Dilated-pupil acquisition, 50-degree field of view, image size 2228x1652, Topcon TRC-50DX, color fundus image — 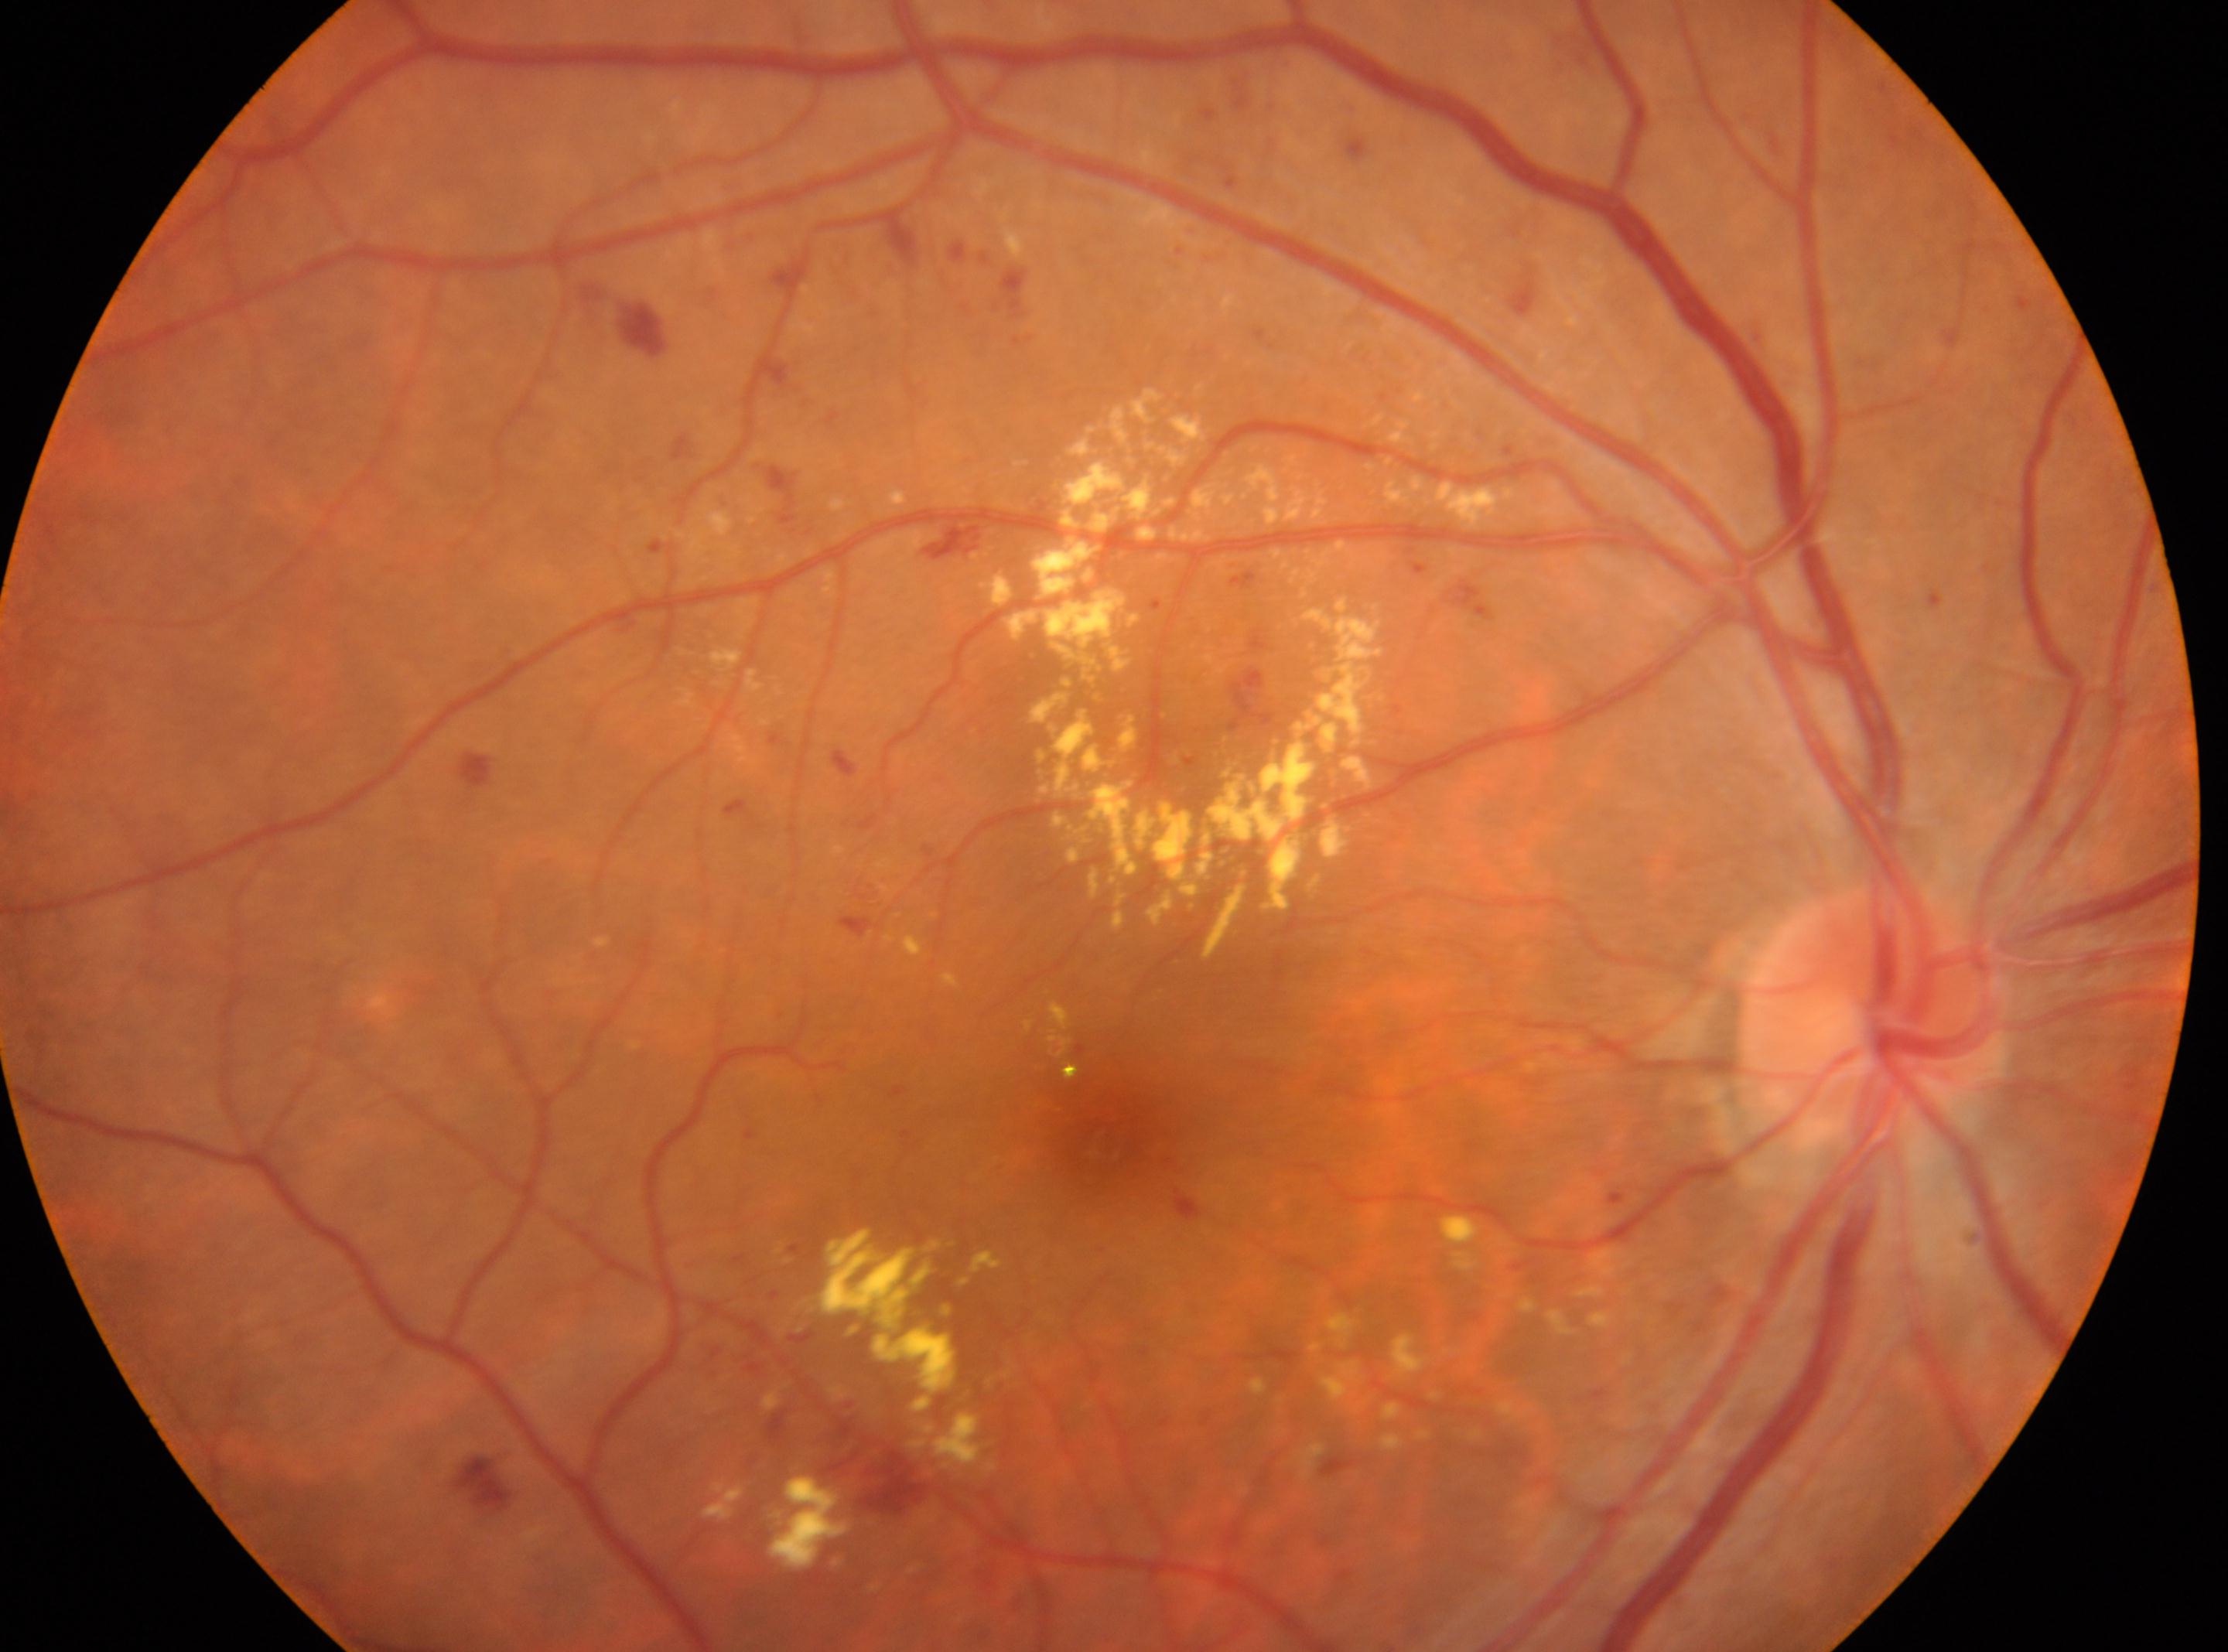 Findings:
* optic nerve head: x=1869, y=1015
* laterality: right eye
* the fovea: x=1100, y=1129
* diabetic retinopathy (DR): severe NPDR (grade 3)